Retinal fundus photograph, 50-degree field of view
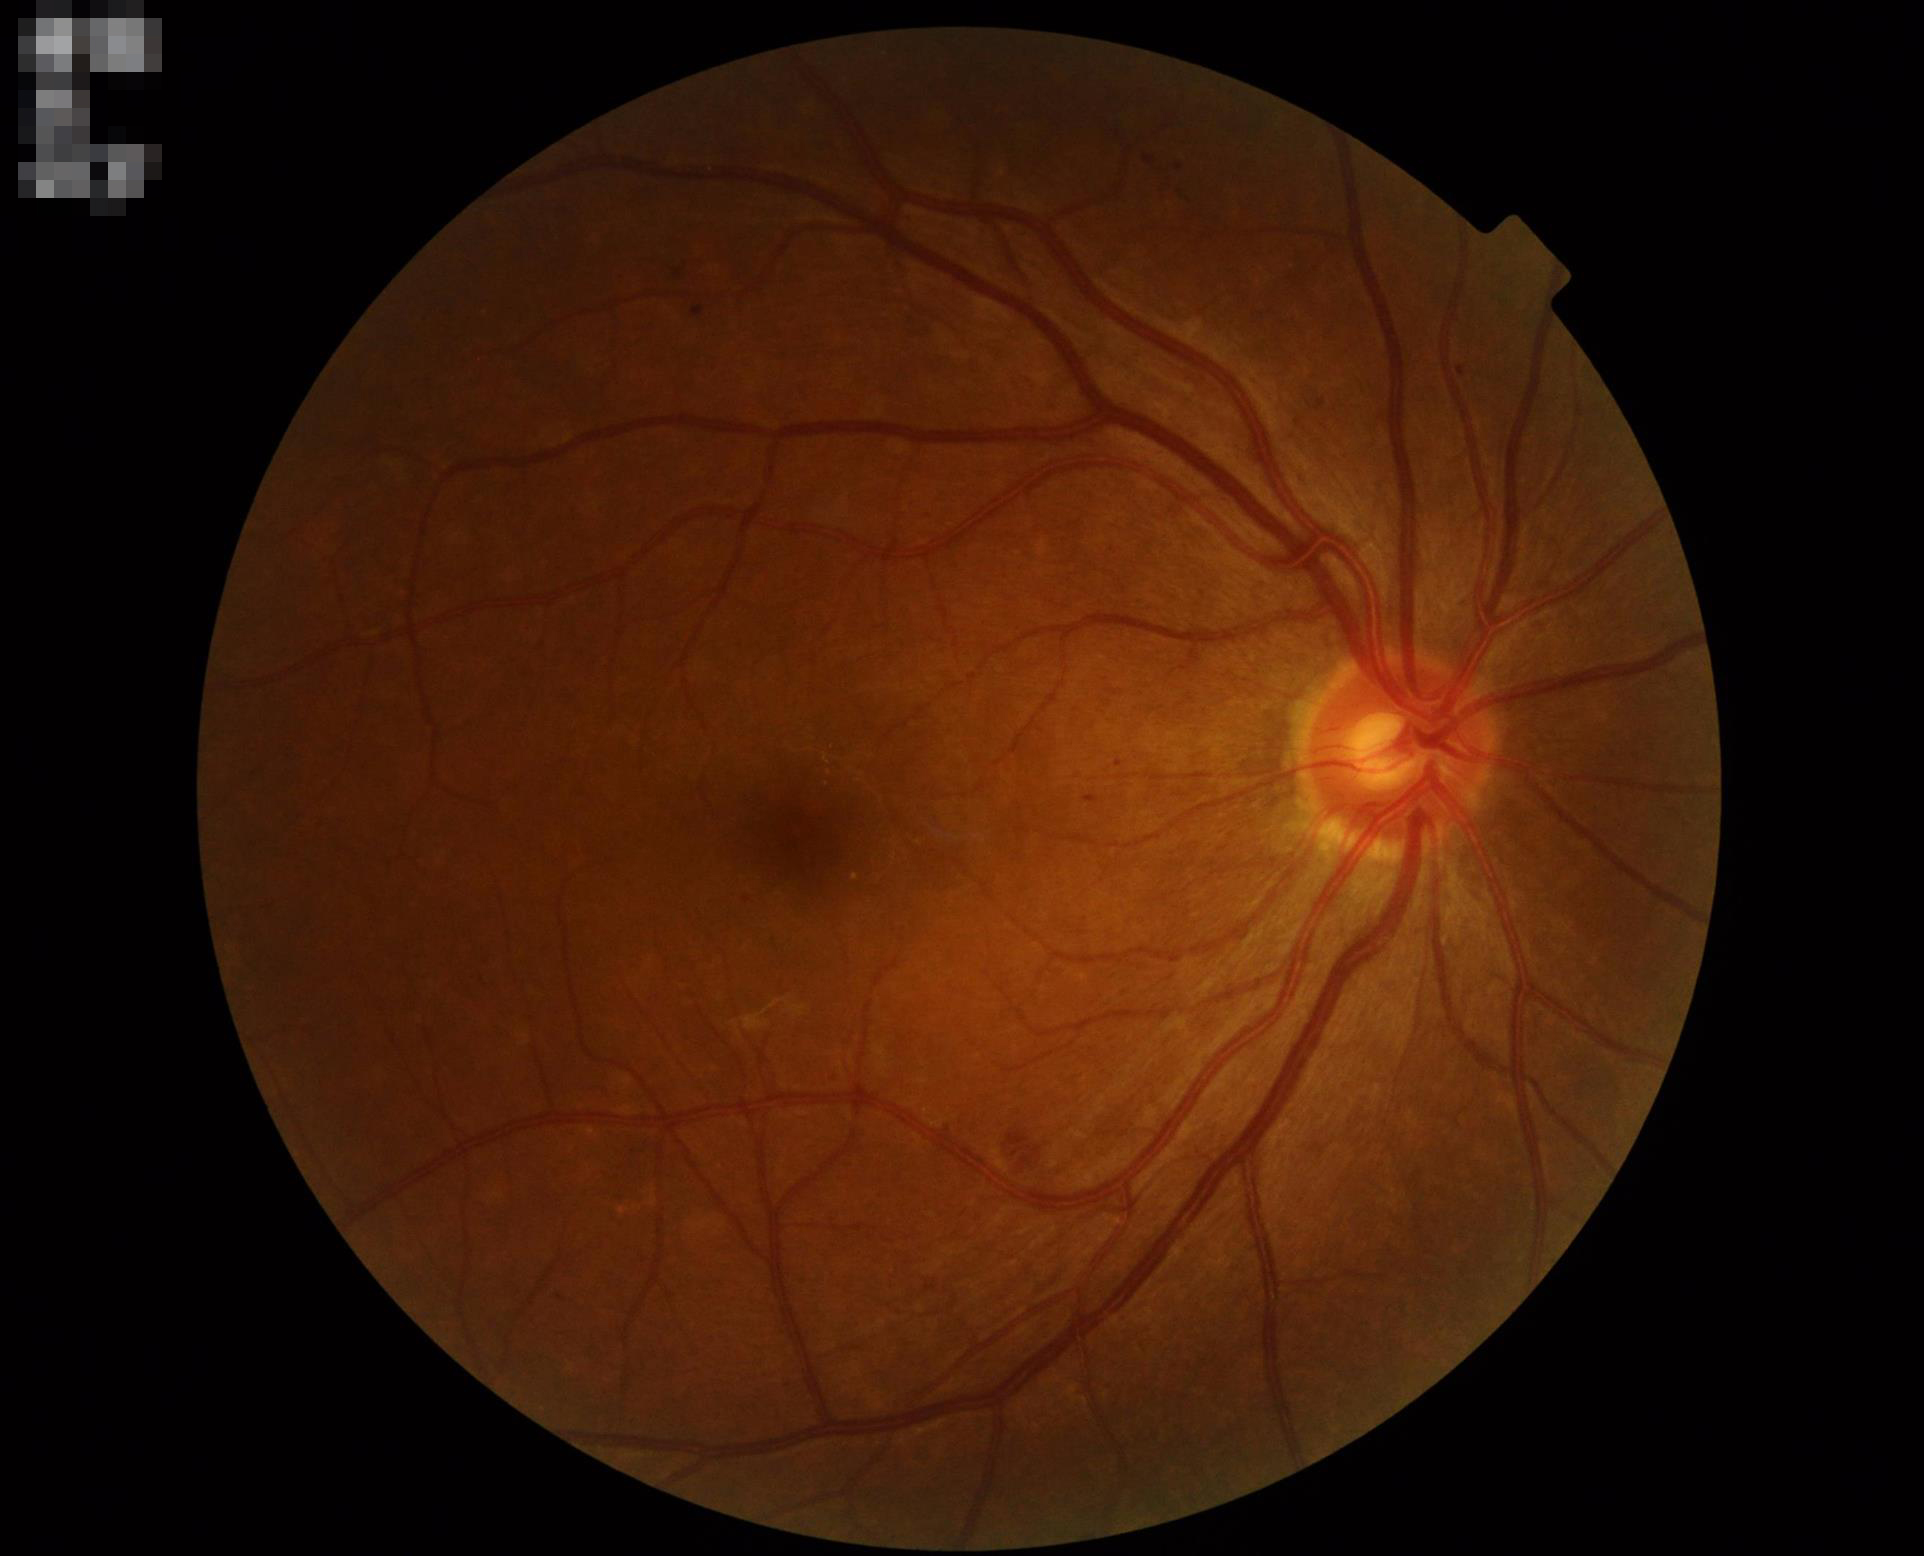 Overall: adequate for clinical interpretation | Illumination/color: even and well-balanced | Clarity: clear with no noticeable blur.